45 degree fundus photograph; posterior pole color fundus photograph; 848x848:
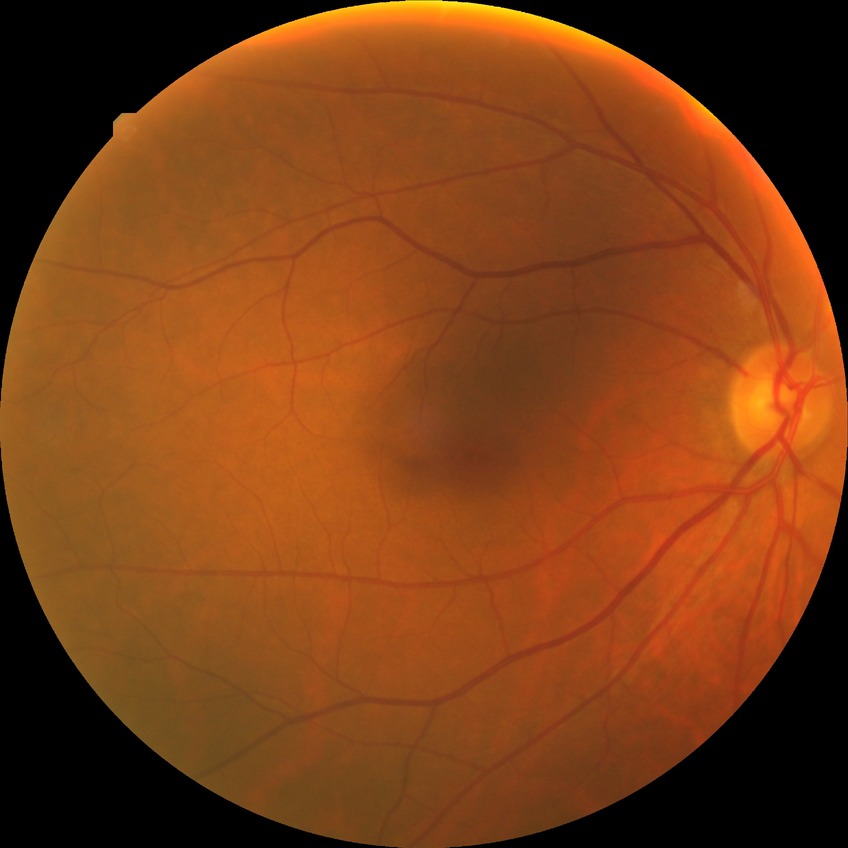
Davis grade is SDR.